45-degree field of view.
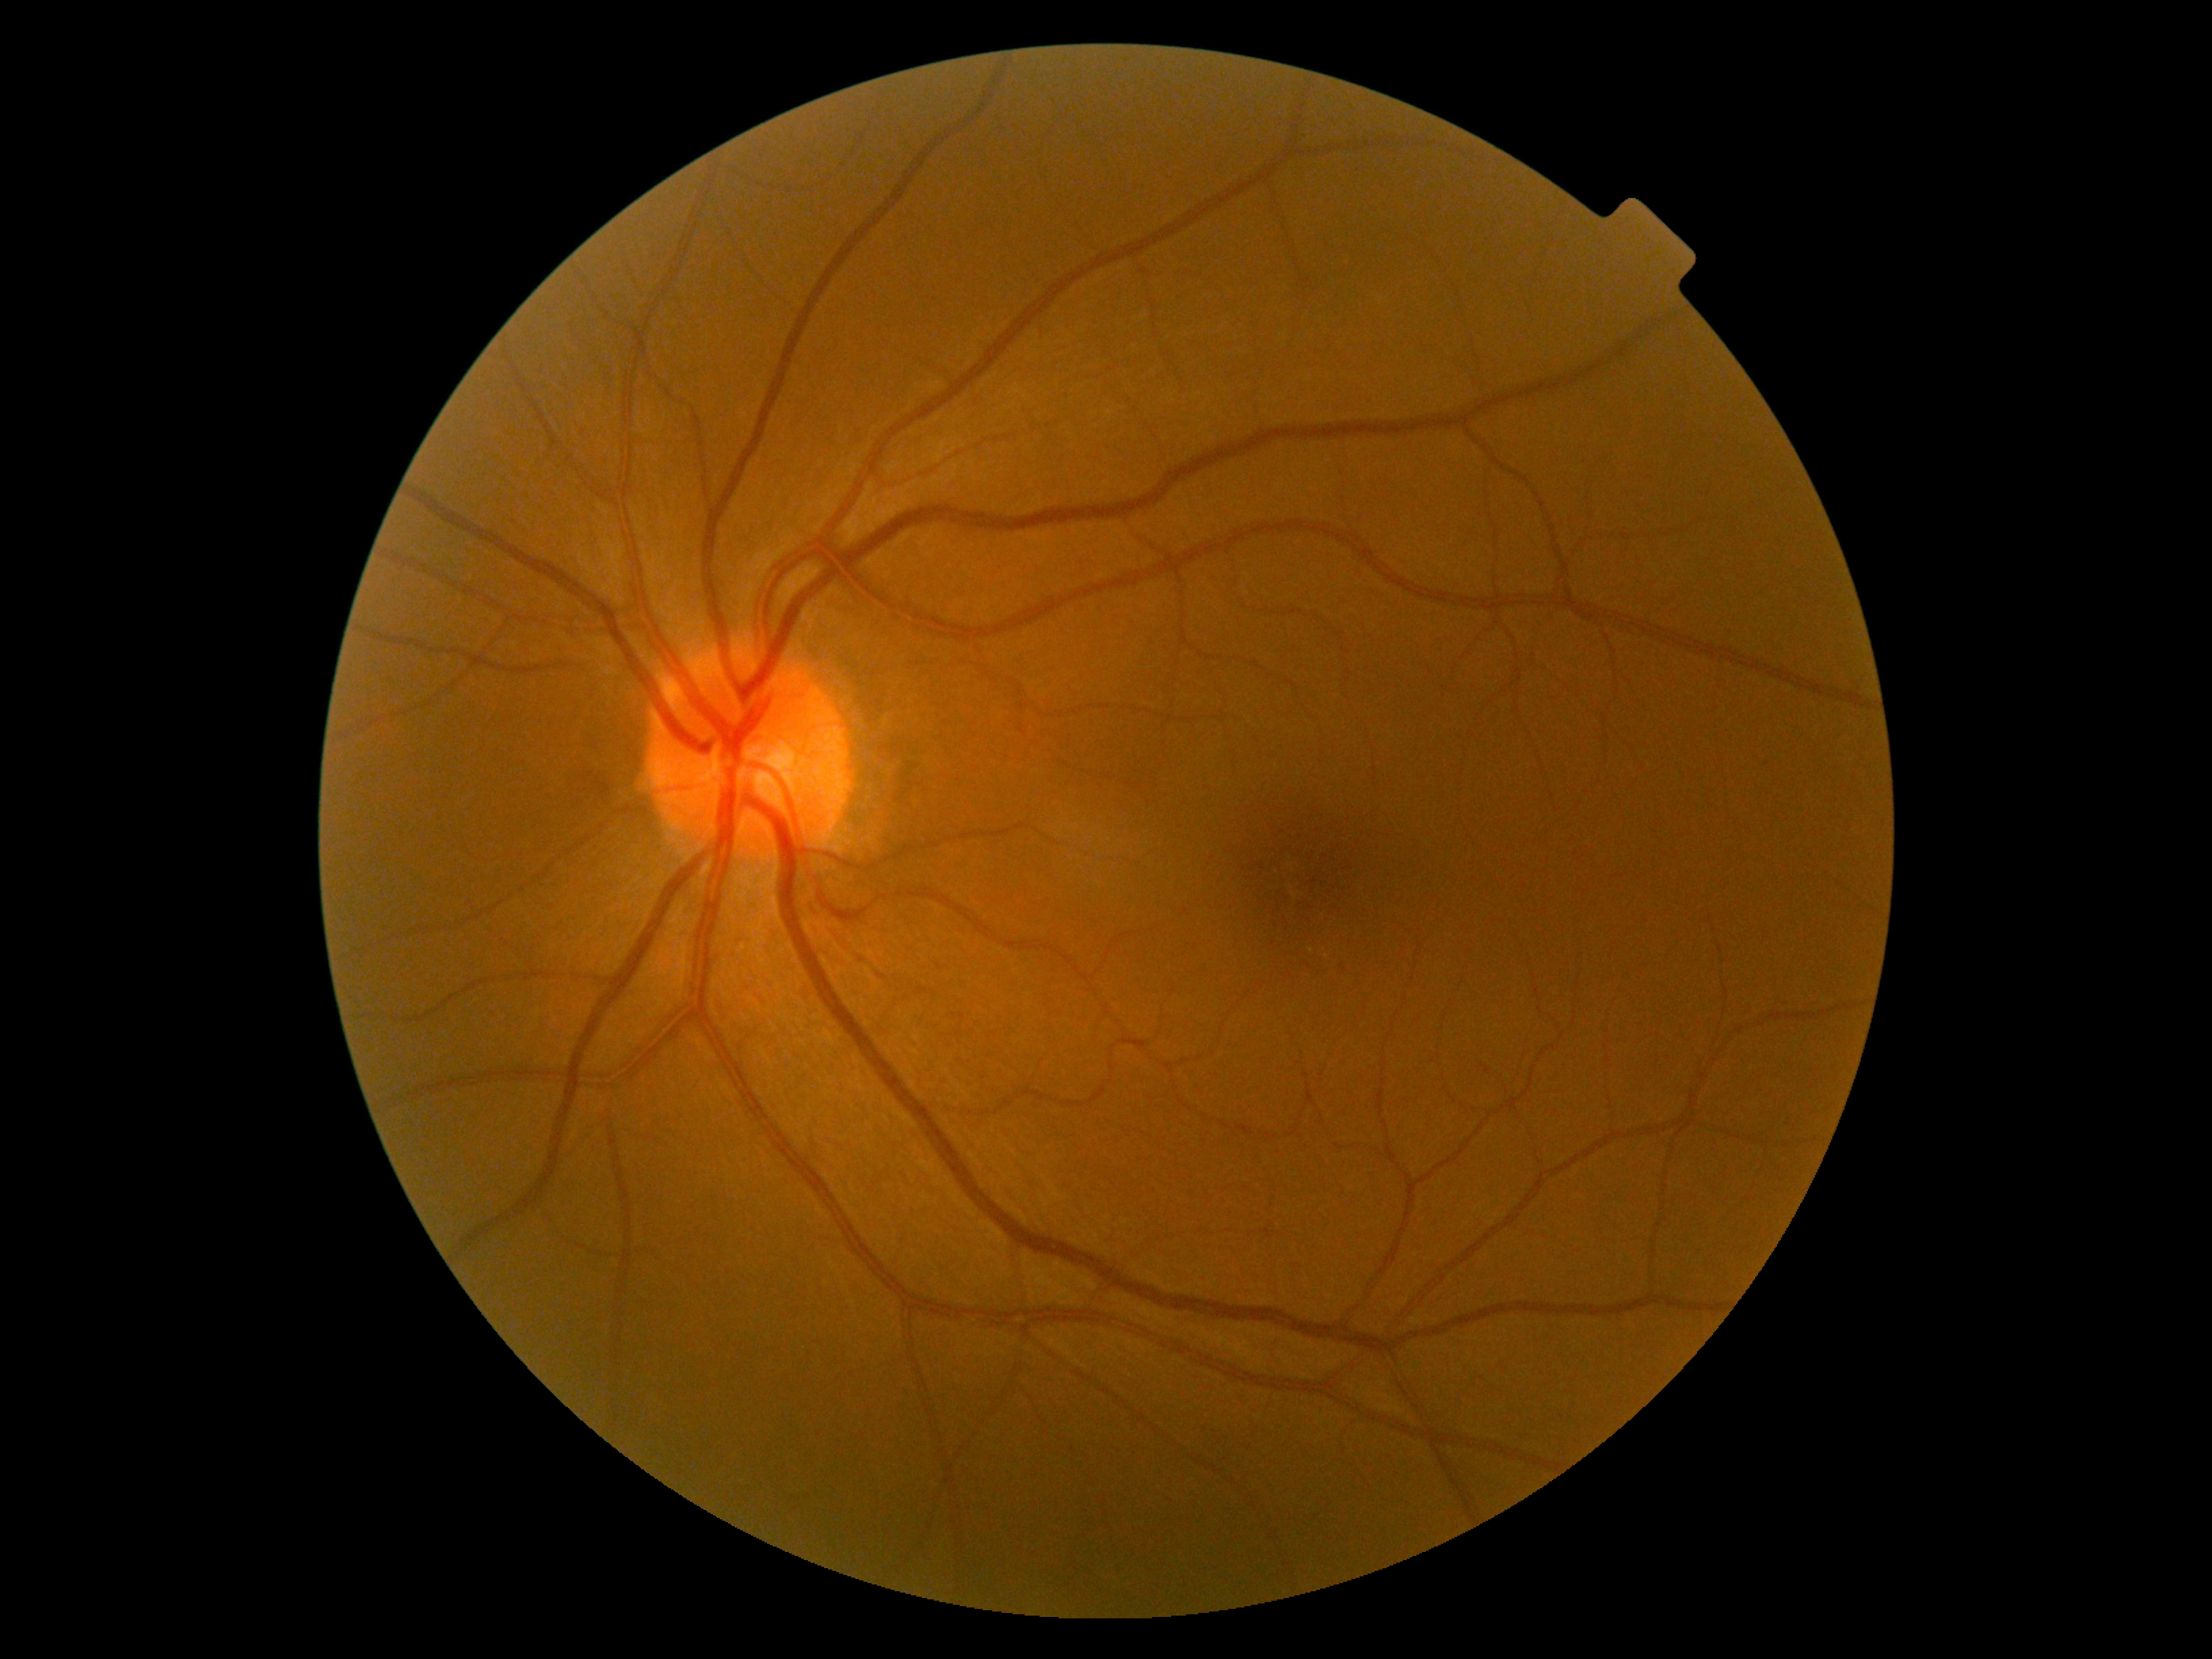 Retinopathy grade: 0.